512x512: 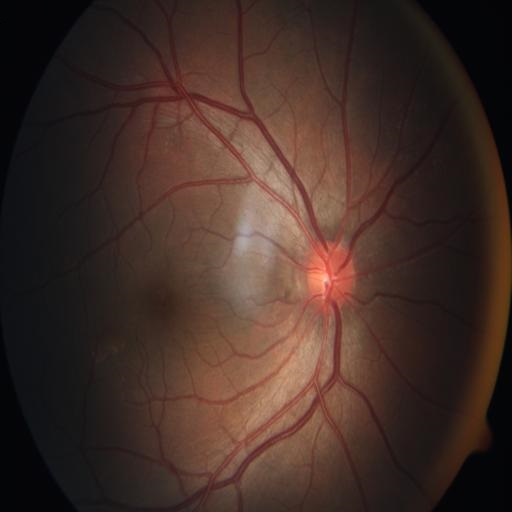 Impression: within normal limits.